45° FOV:
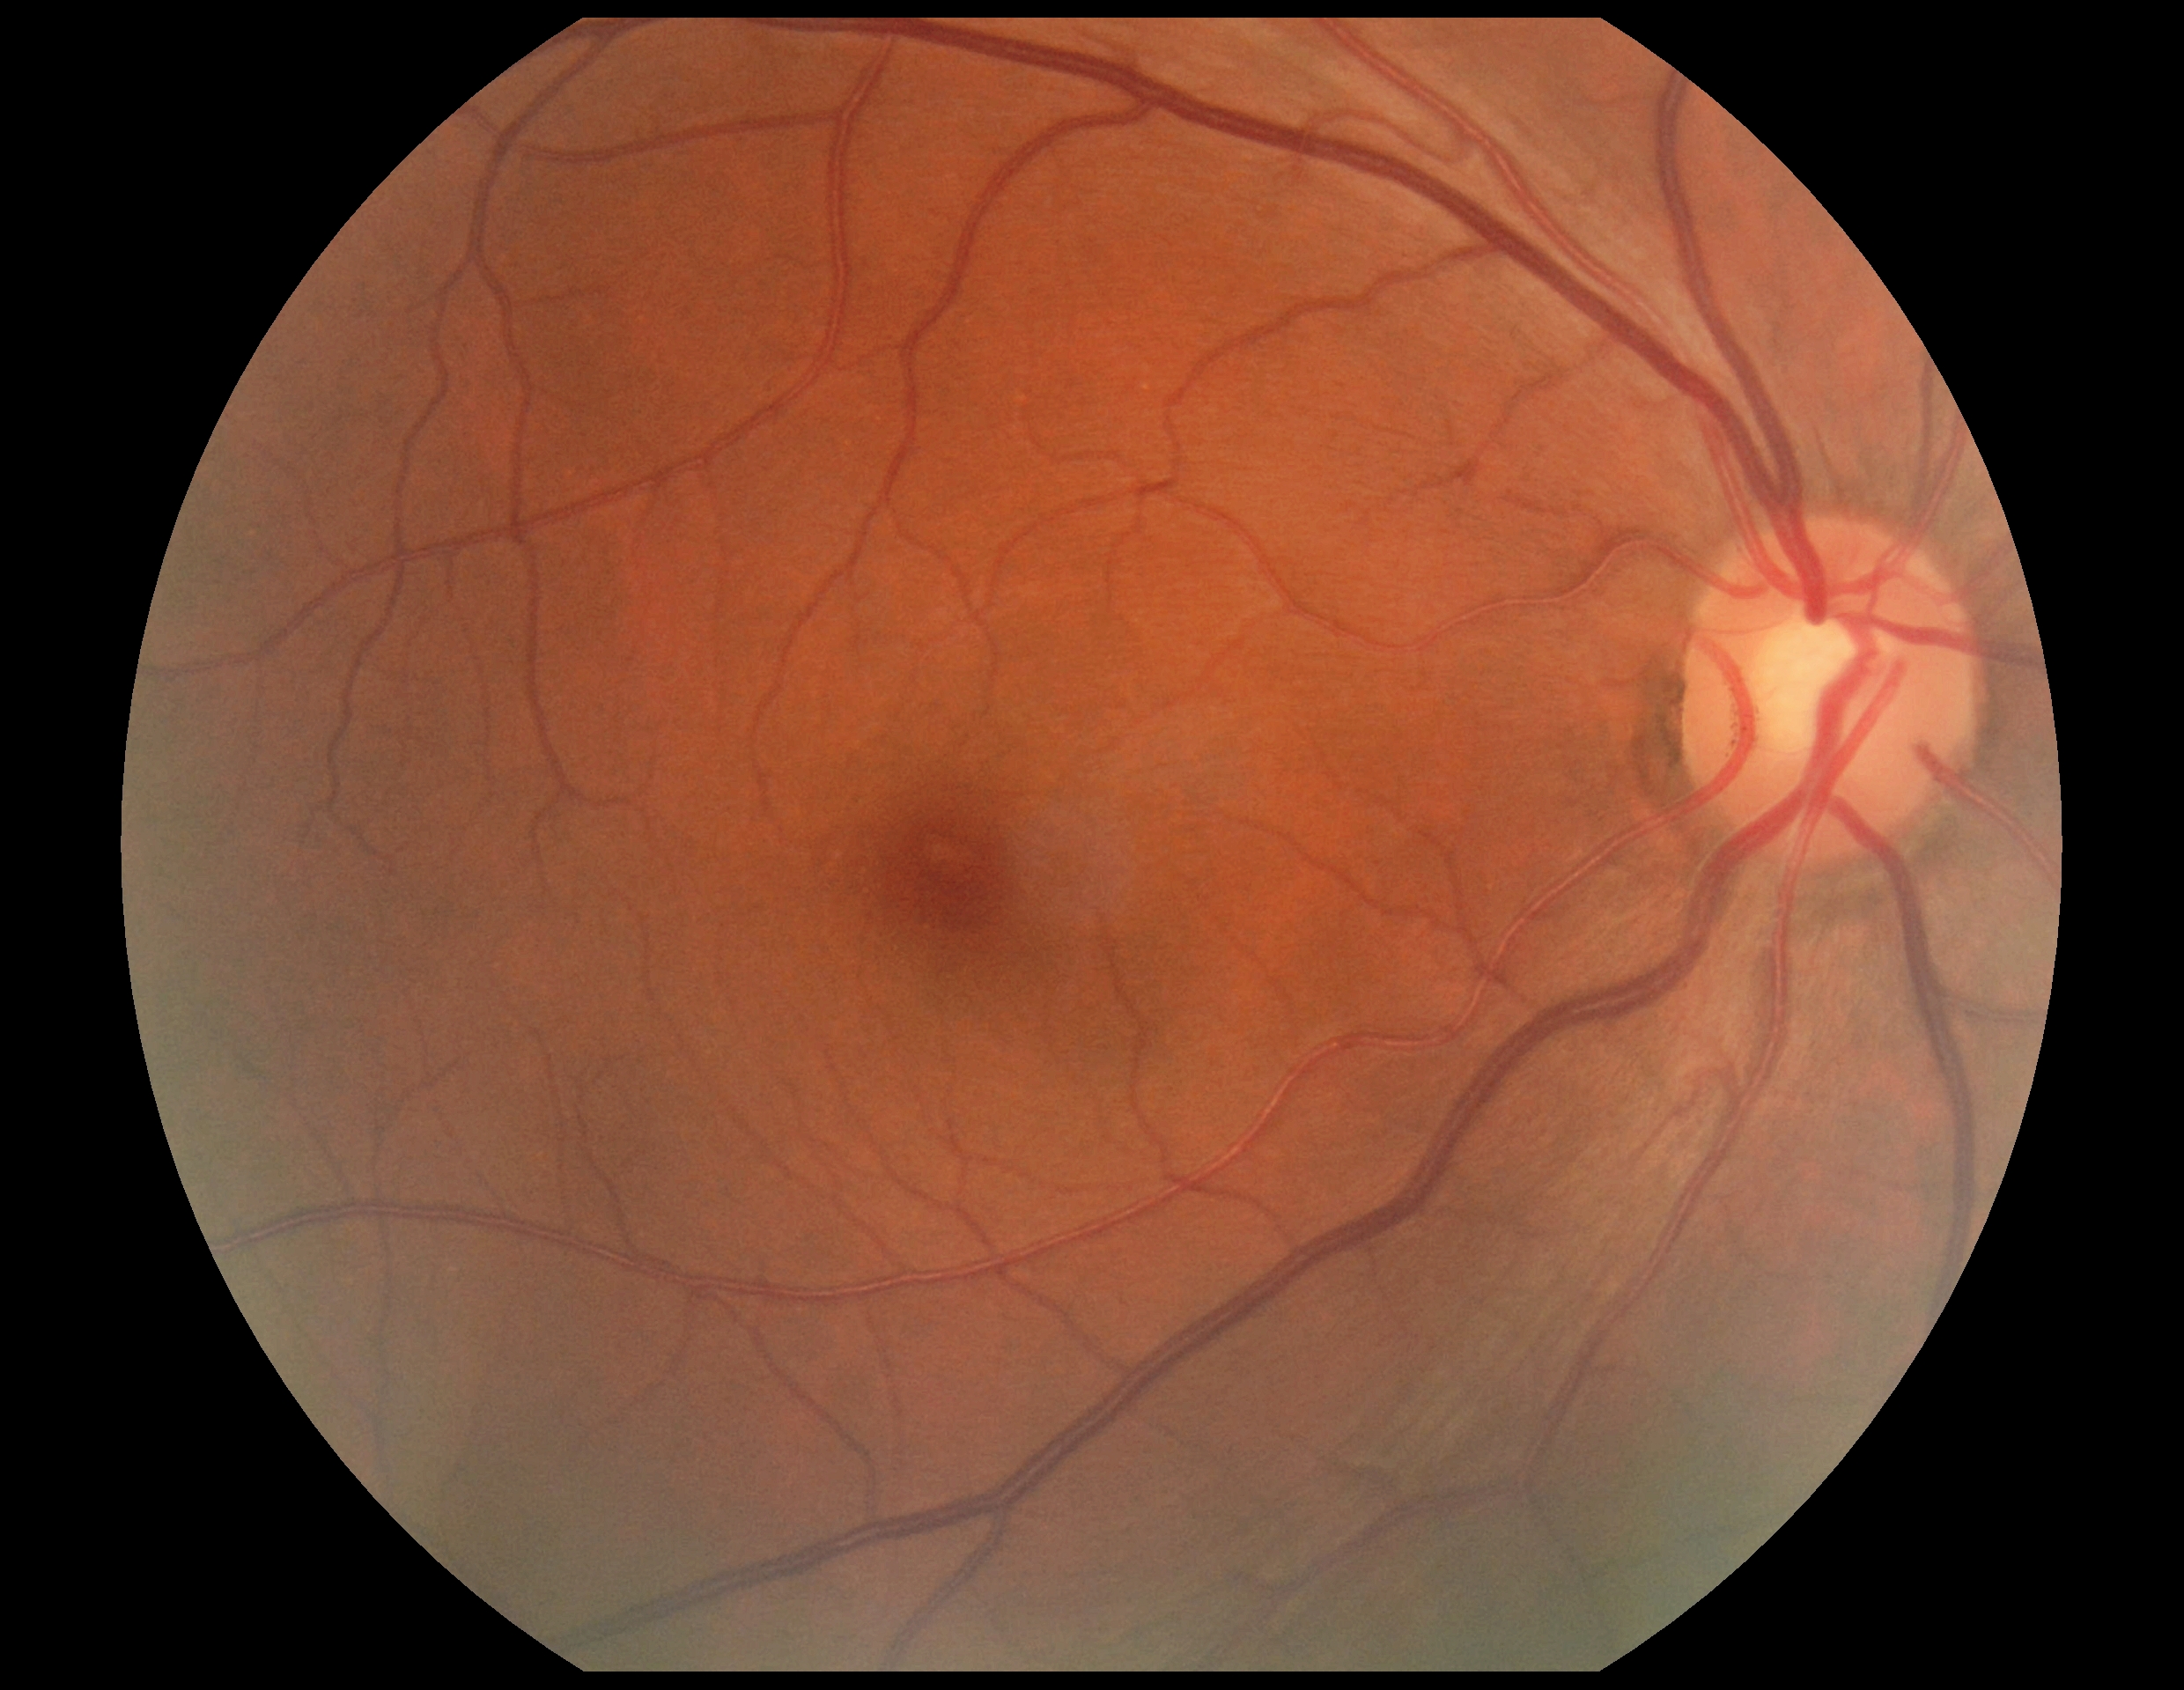 Diabetic retinopathy grade: 0 (no apparent retinopathy).